Nonmydriatic fundus photograph, 45 degree fundus photograph.
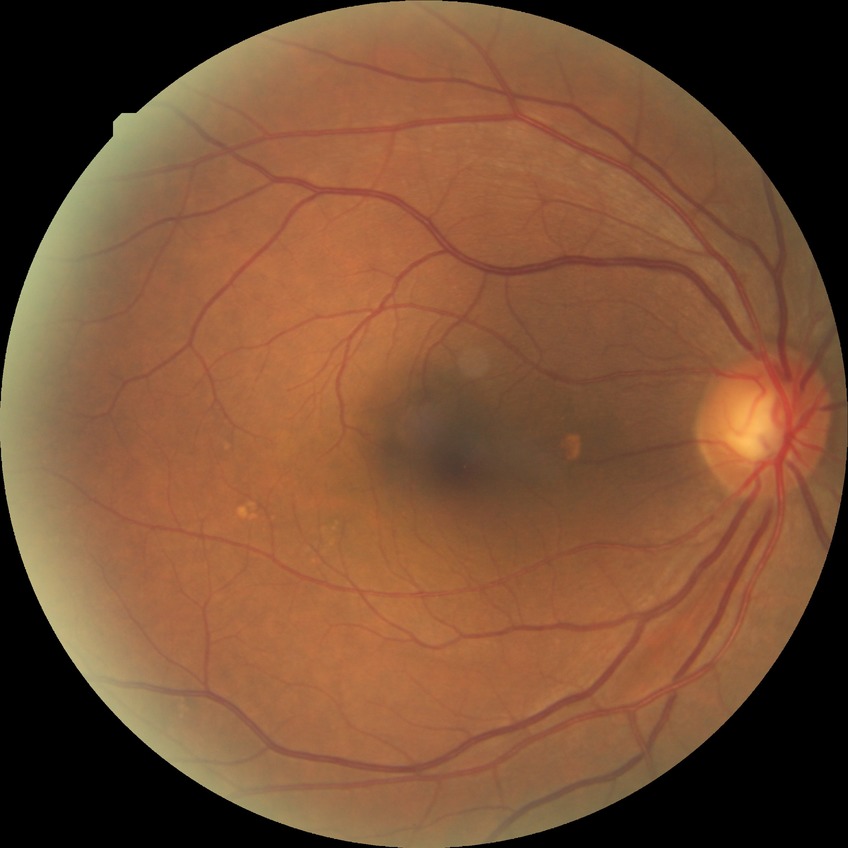
Retinopathy grade is no diabetic retinopathy.